Remidio smartphone fundus camera. Image size 1659x2212:
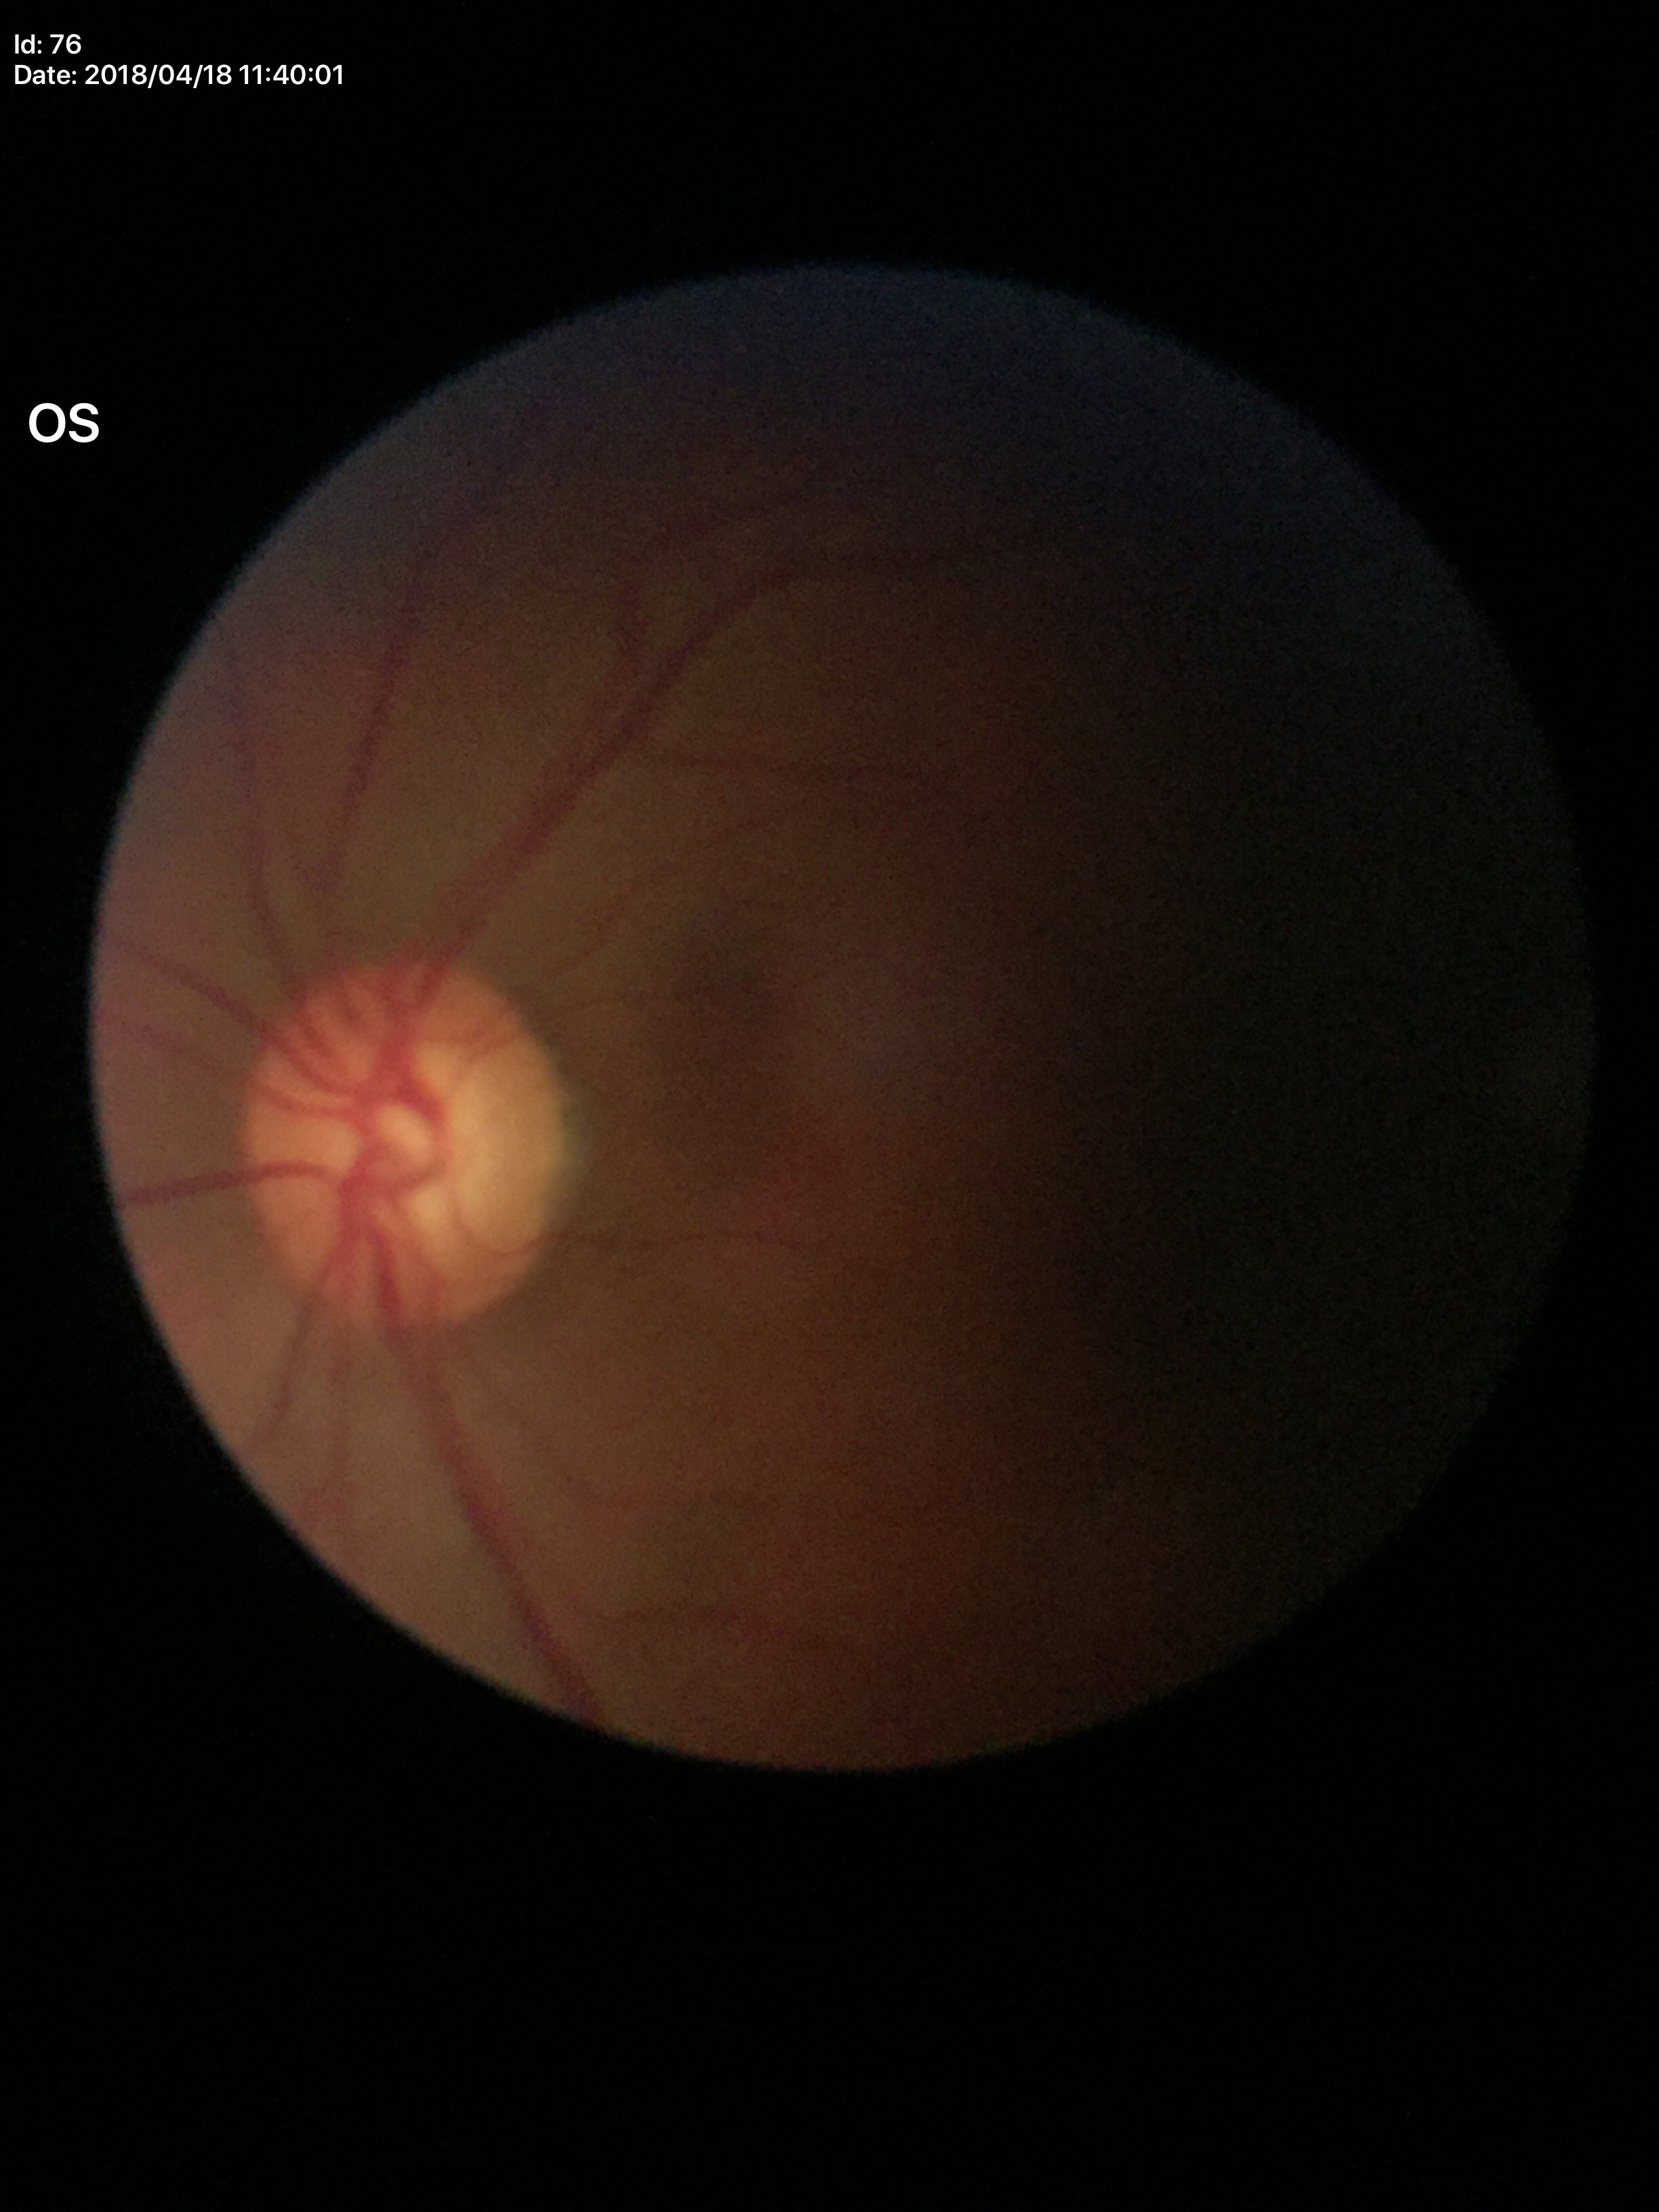   glaucoma_decision: suspect
  vcdr: 0.60